45° FOV · 848x848px · nonmydriatic:
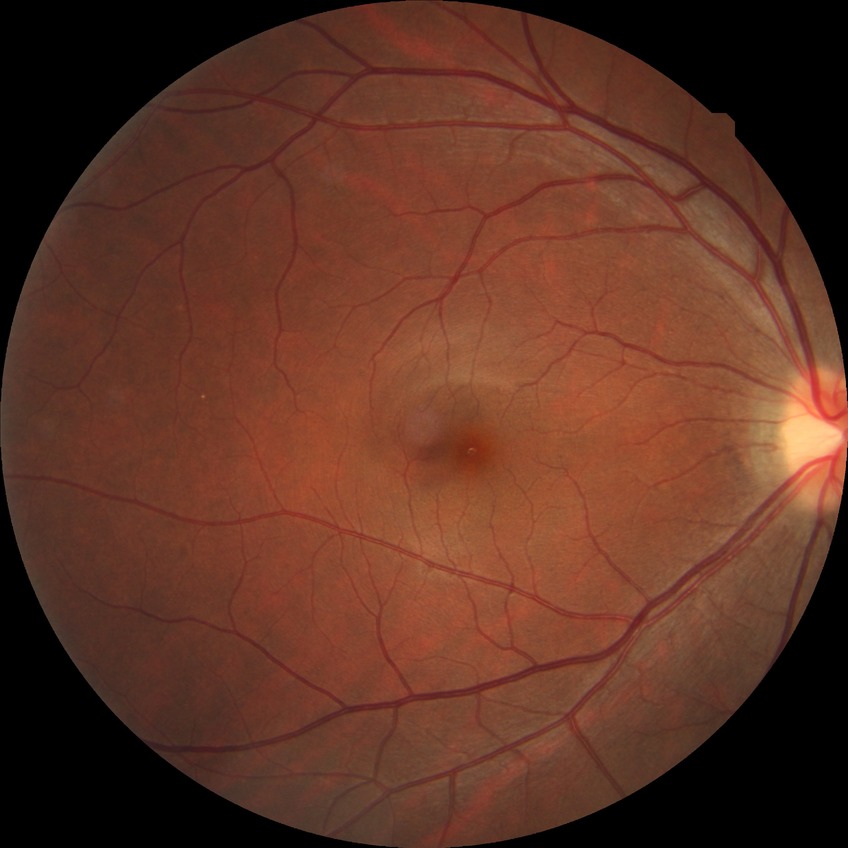 No diabetic retinal disease findings.
DR grade is NDR.